Image size 2048x1536 — 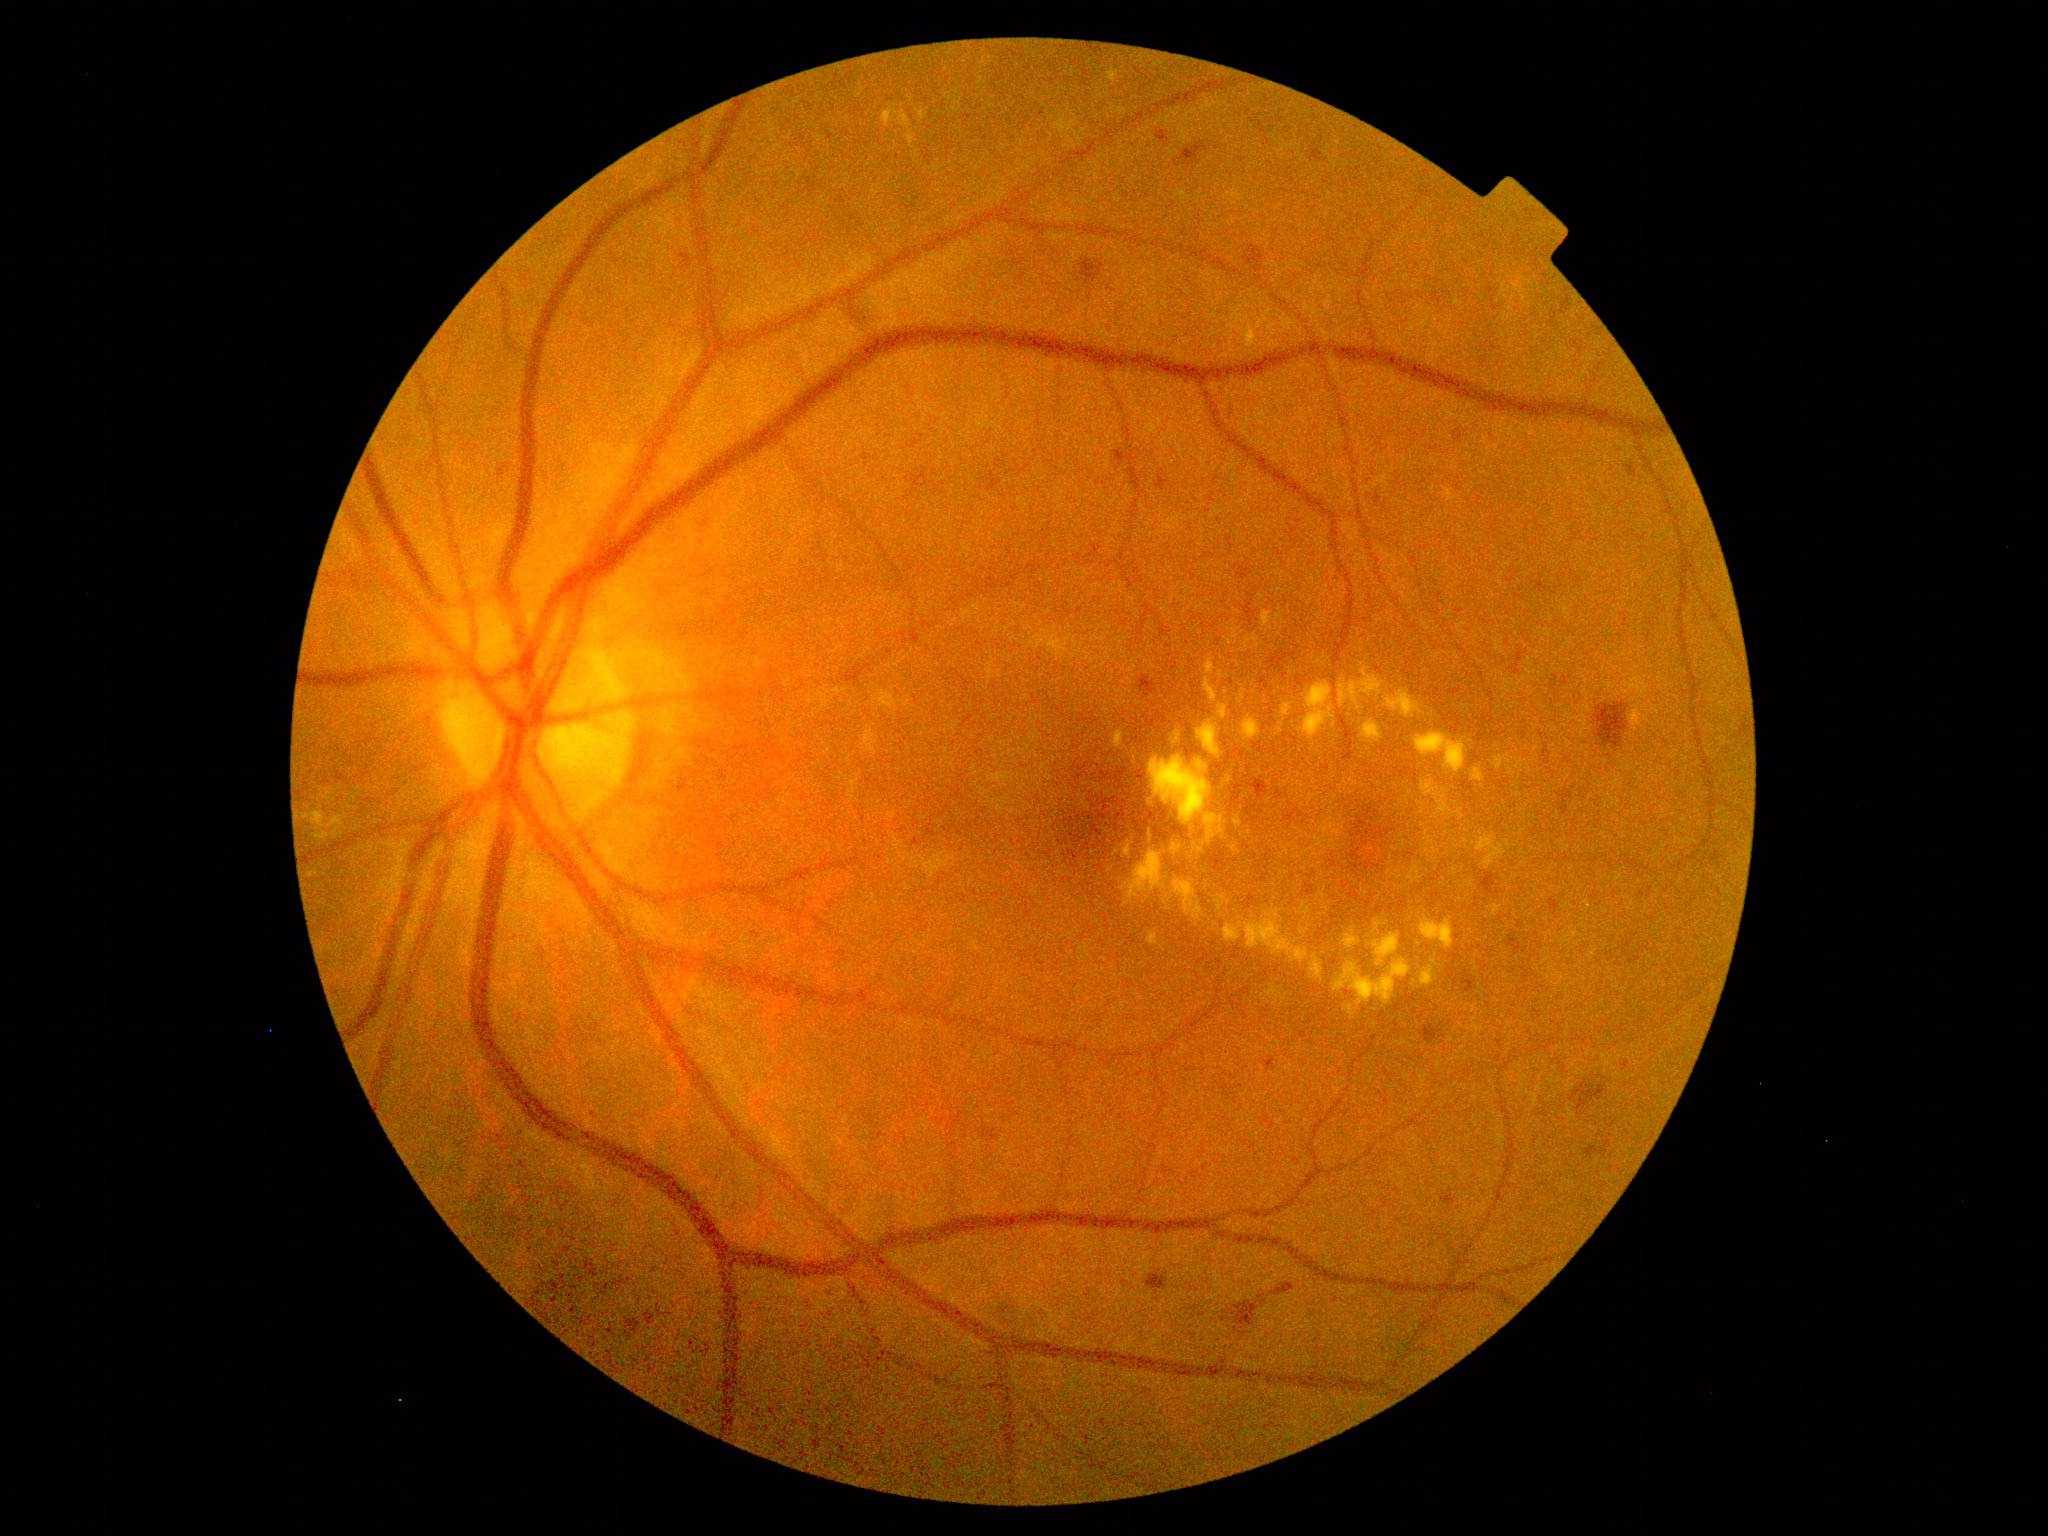 DR stage: 2
Lesions identified (partial list):
EXs (partial): 1420,916,1454,951; 1224,909,1310,964; 1297,902,1312,917; 1171,843,1182,856; 1255,770,1264,775; 1283,776,1292,786; 1136,994,1145,1001; 1262,608,1284,627; 1420,959,1439,987
Small EXs near {"x": 1519, "y": 795}; {"x": 1368, "y": 749}; {"x": 1123, "y": 672}; {"x": 1467, "y": 831}; {"x": 1229, "y": 903}; {"x": 1380, "y": 784}; {"x": 1112, "y": 681}; {"x": 1305, "y": 869}; {"x": 1507, "y": 709}; {"x": 1446, "y": 834}
HEs (partial): 1133,806,1169,838; 681,255,693,270; 1447,967,1456,979; 1246,778,1269,800; 1328,861,1337,868; 1264,1058,1277,1075; 1365,856,1381,871; 1557,790,1573,816; 1156,470,1171,491; 1533,583,1547,593; 1115,451,1138,467; 1284,809,1304,826; 1139,792,1148,802; 1179,142,1208,167
Small HEs near {"x": 1073, "y": 770}; {"x": 554, "y": 1302}; {"x": 1369, "y": 903}; {"x": 1355, "y": 845}